Captured on a Nidek AFC-330 fundus camera, image size 240x240: 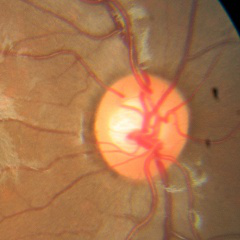
Glaucoma diagnosis = no signs of glaucoma.